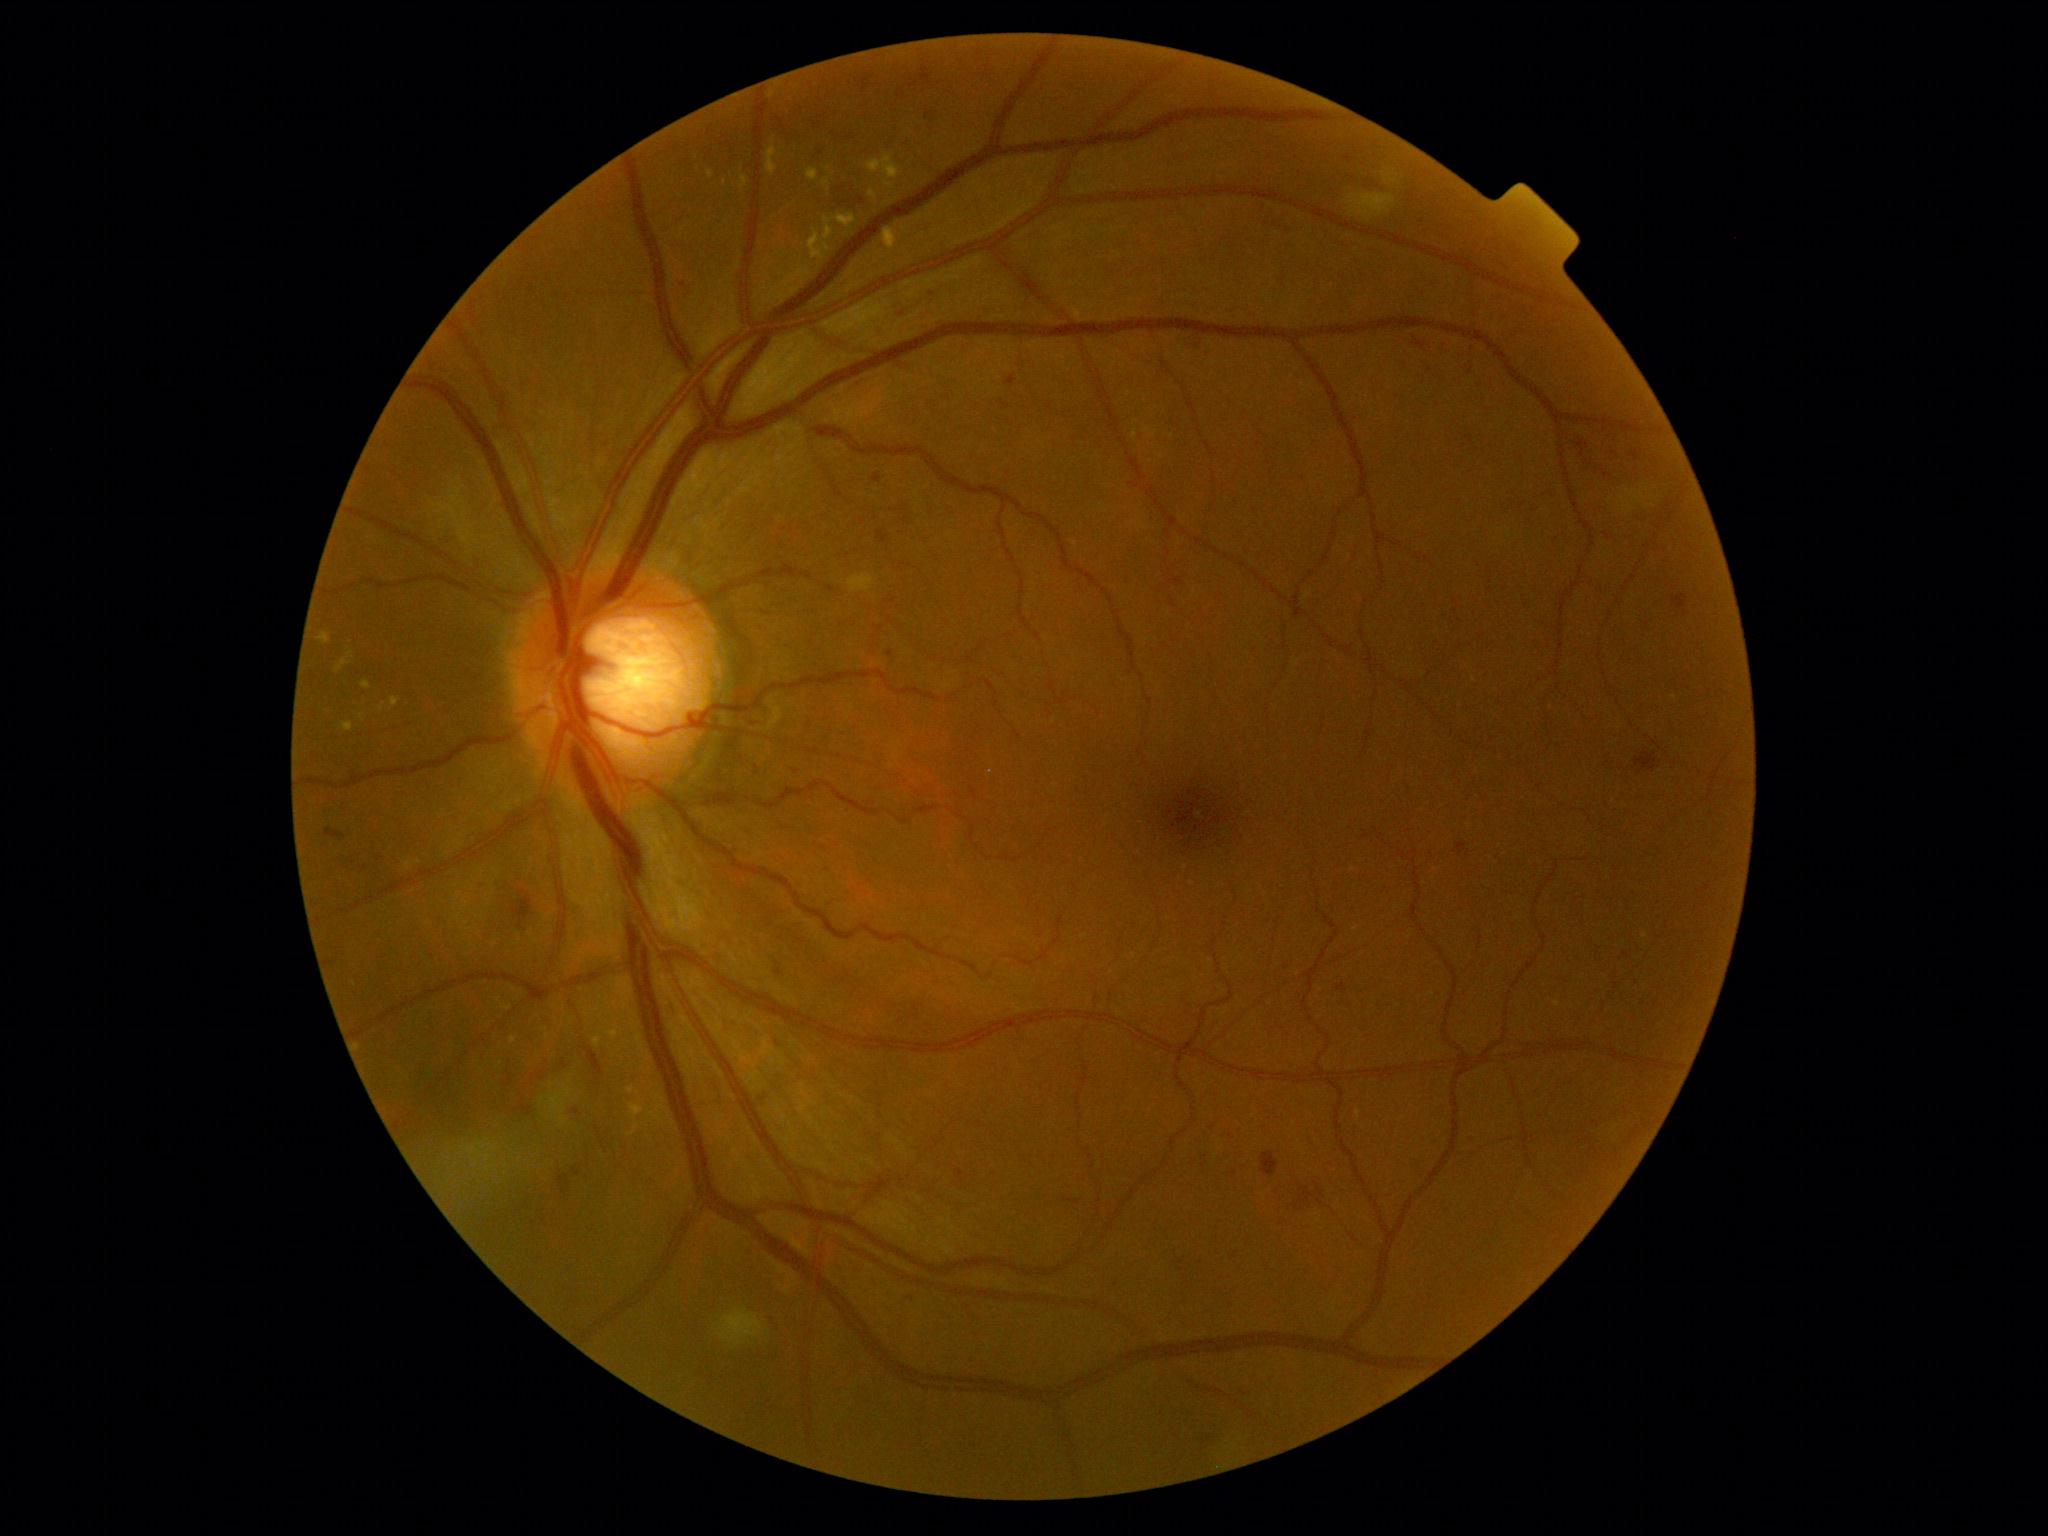

Diabetic retinopathy (DR): grade 2 — more than just microaneurysms but less than severe NPDR.